2048x1536px: 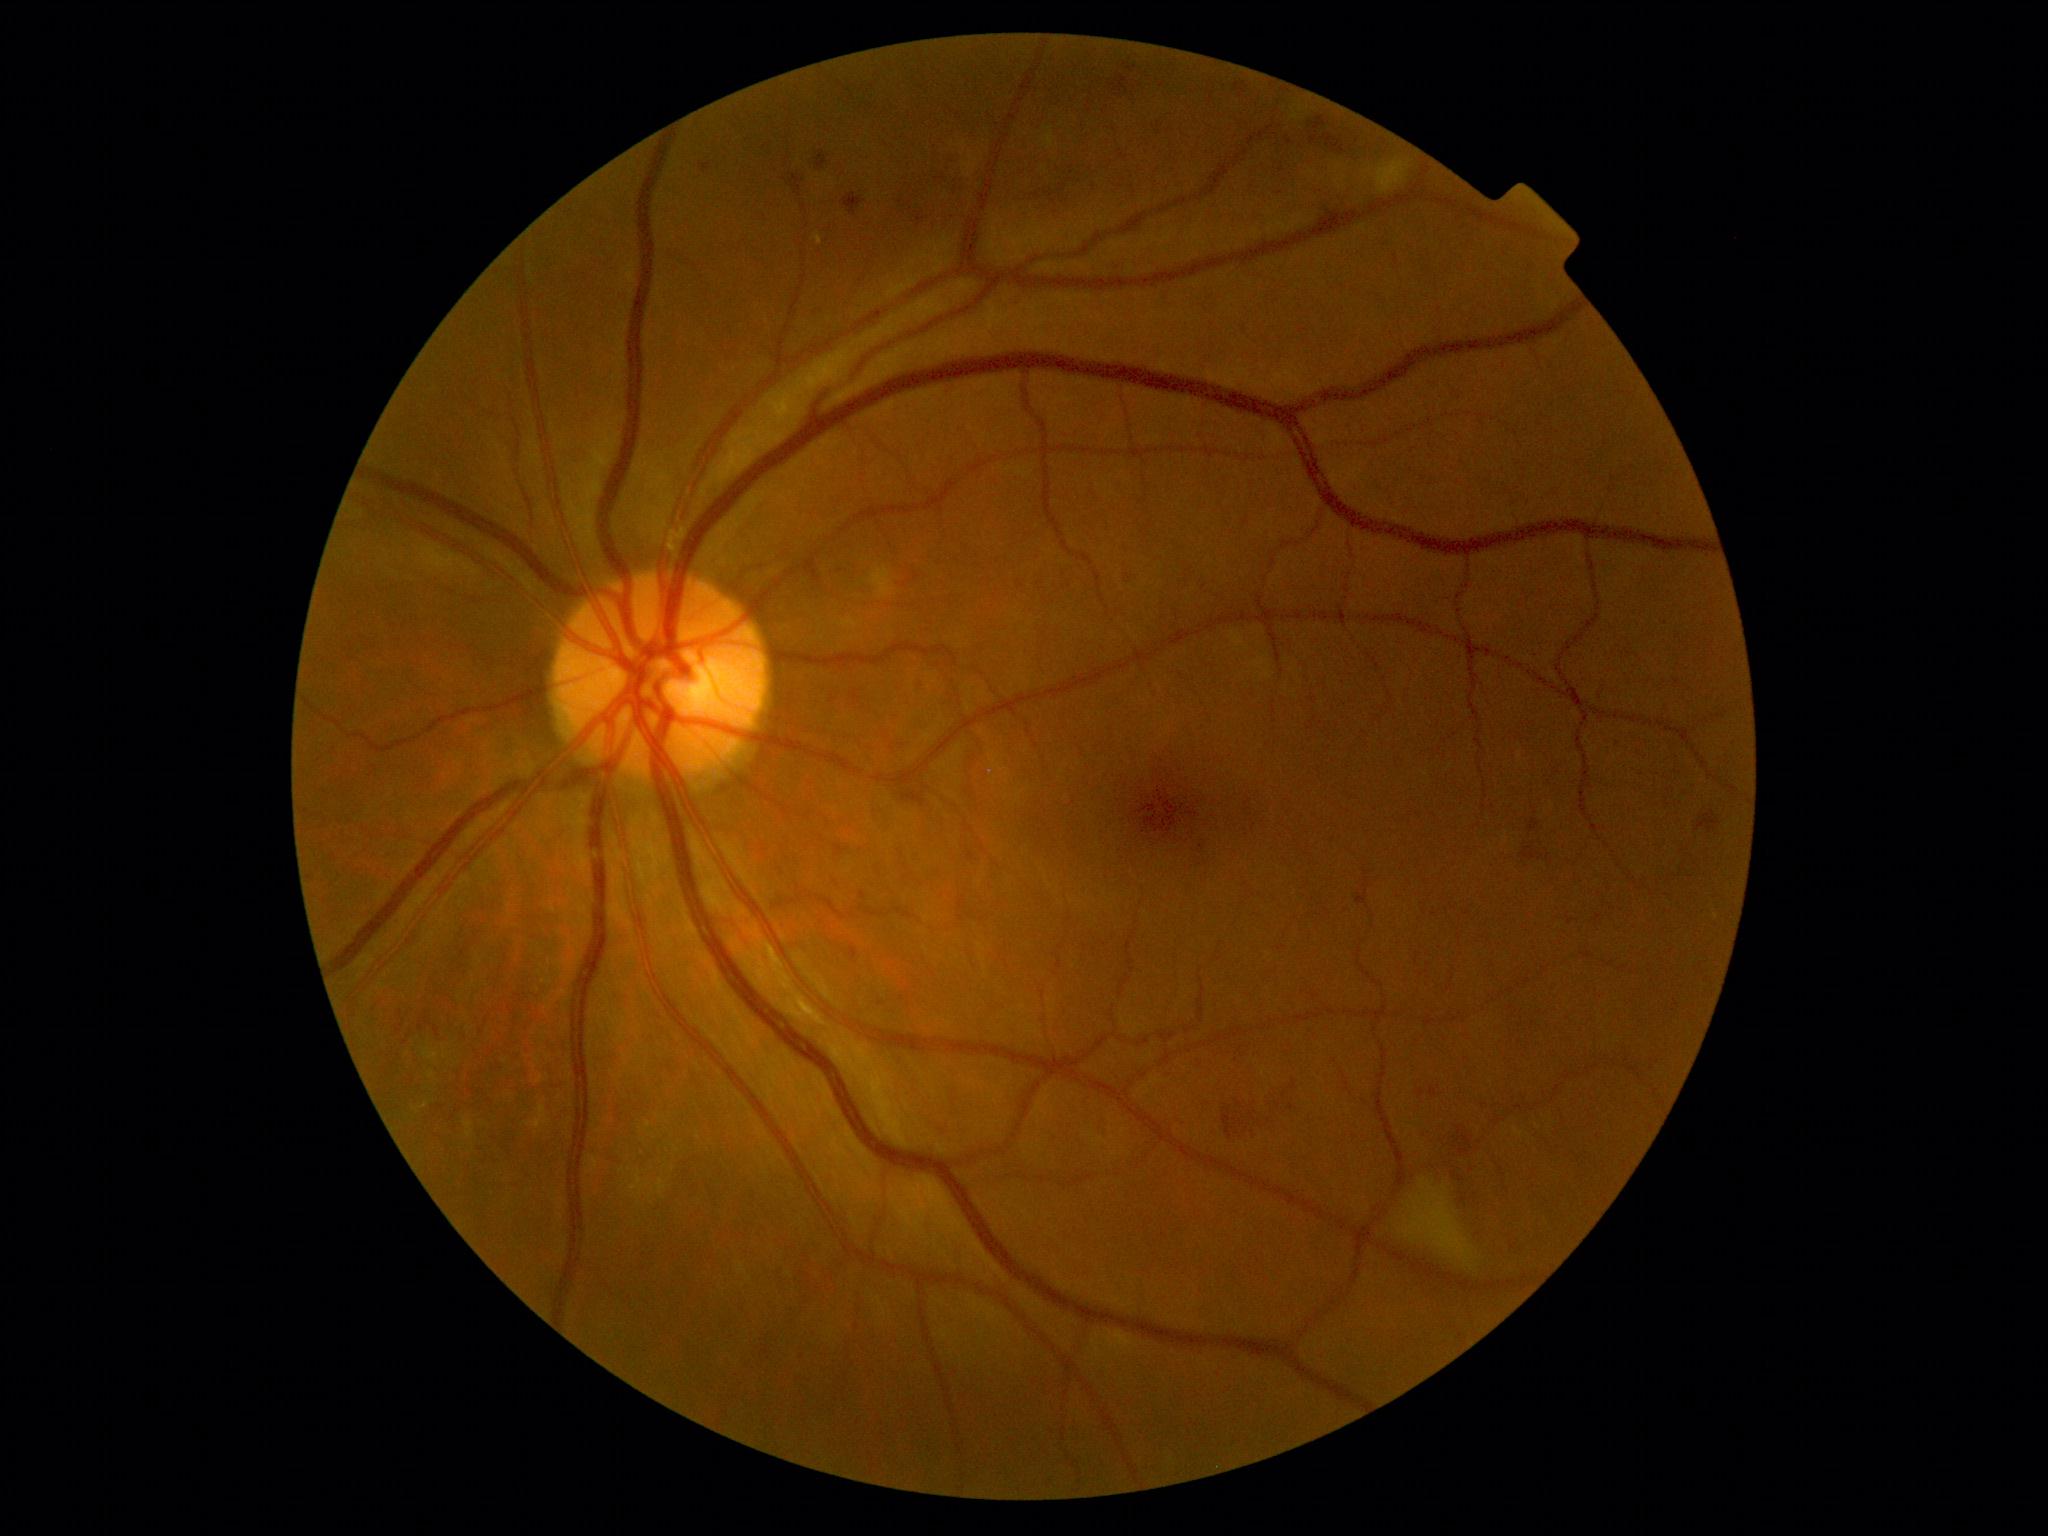

DR stage: 2/4. The retinopathy is classified as non-proliferative diabetic retinopathy.